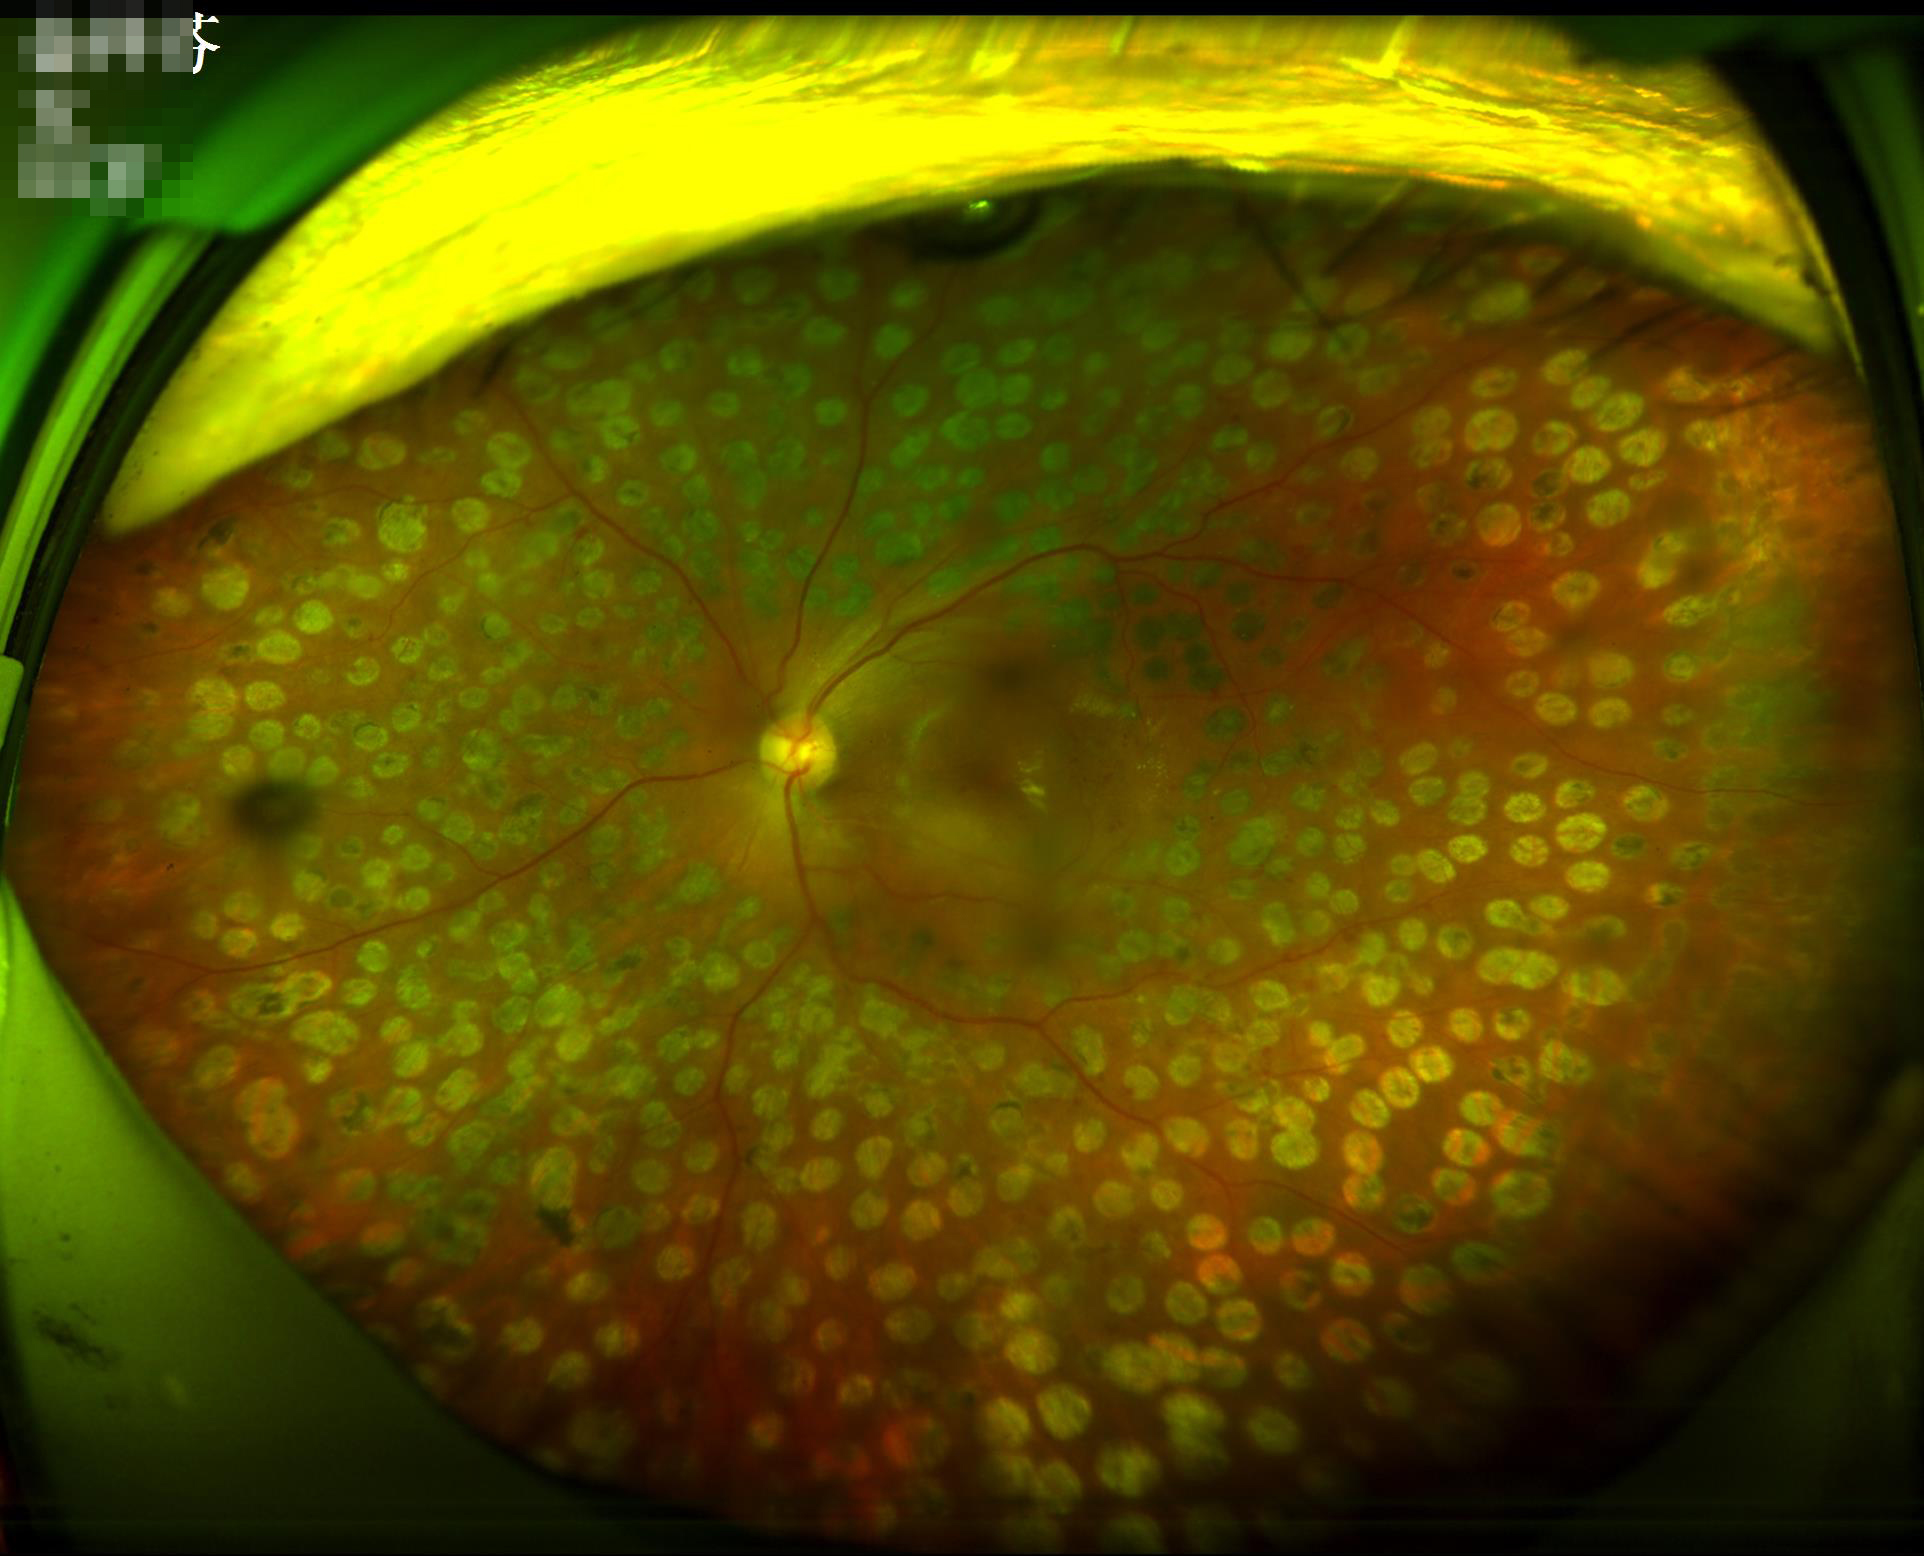 Overall quality is good and the image is gradable.
The image is clear.
Illumination and color balance are good.